FOV: 45 degrees:
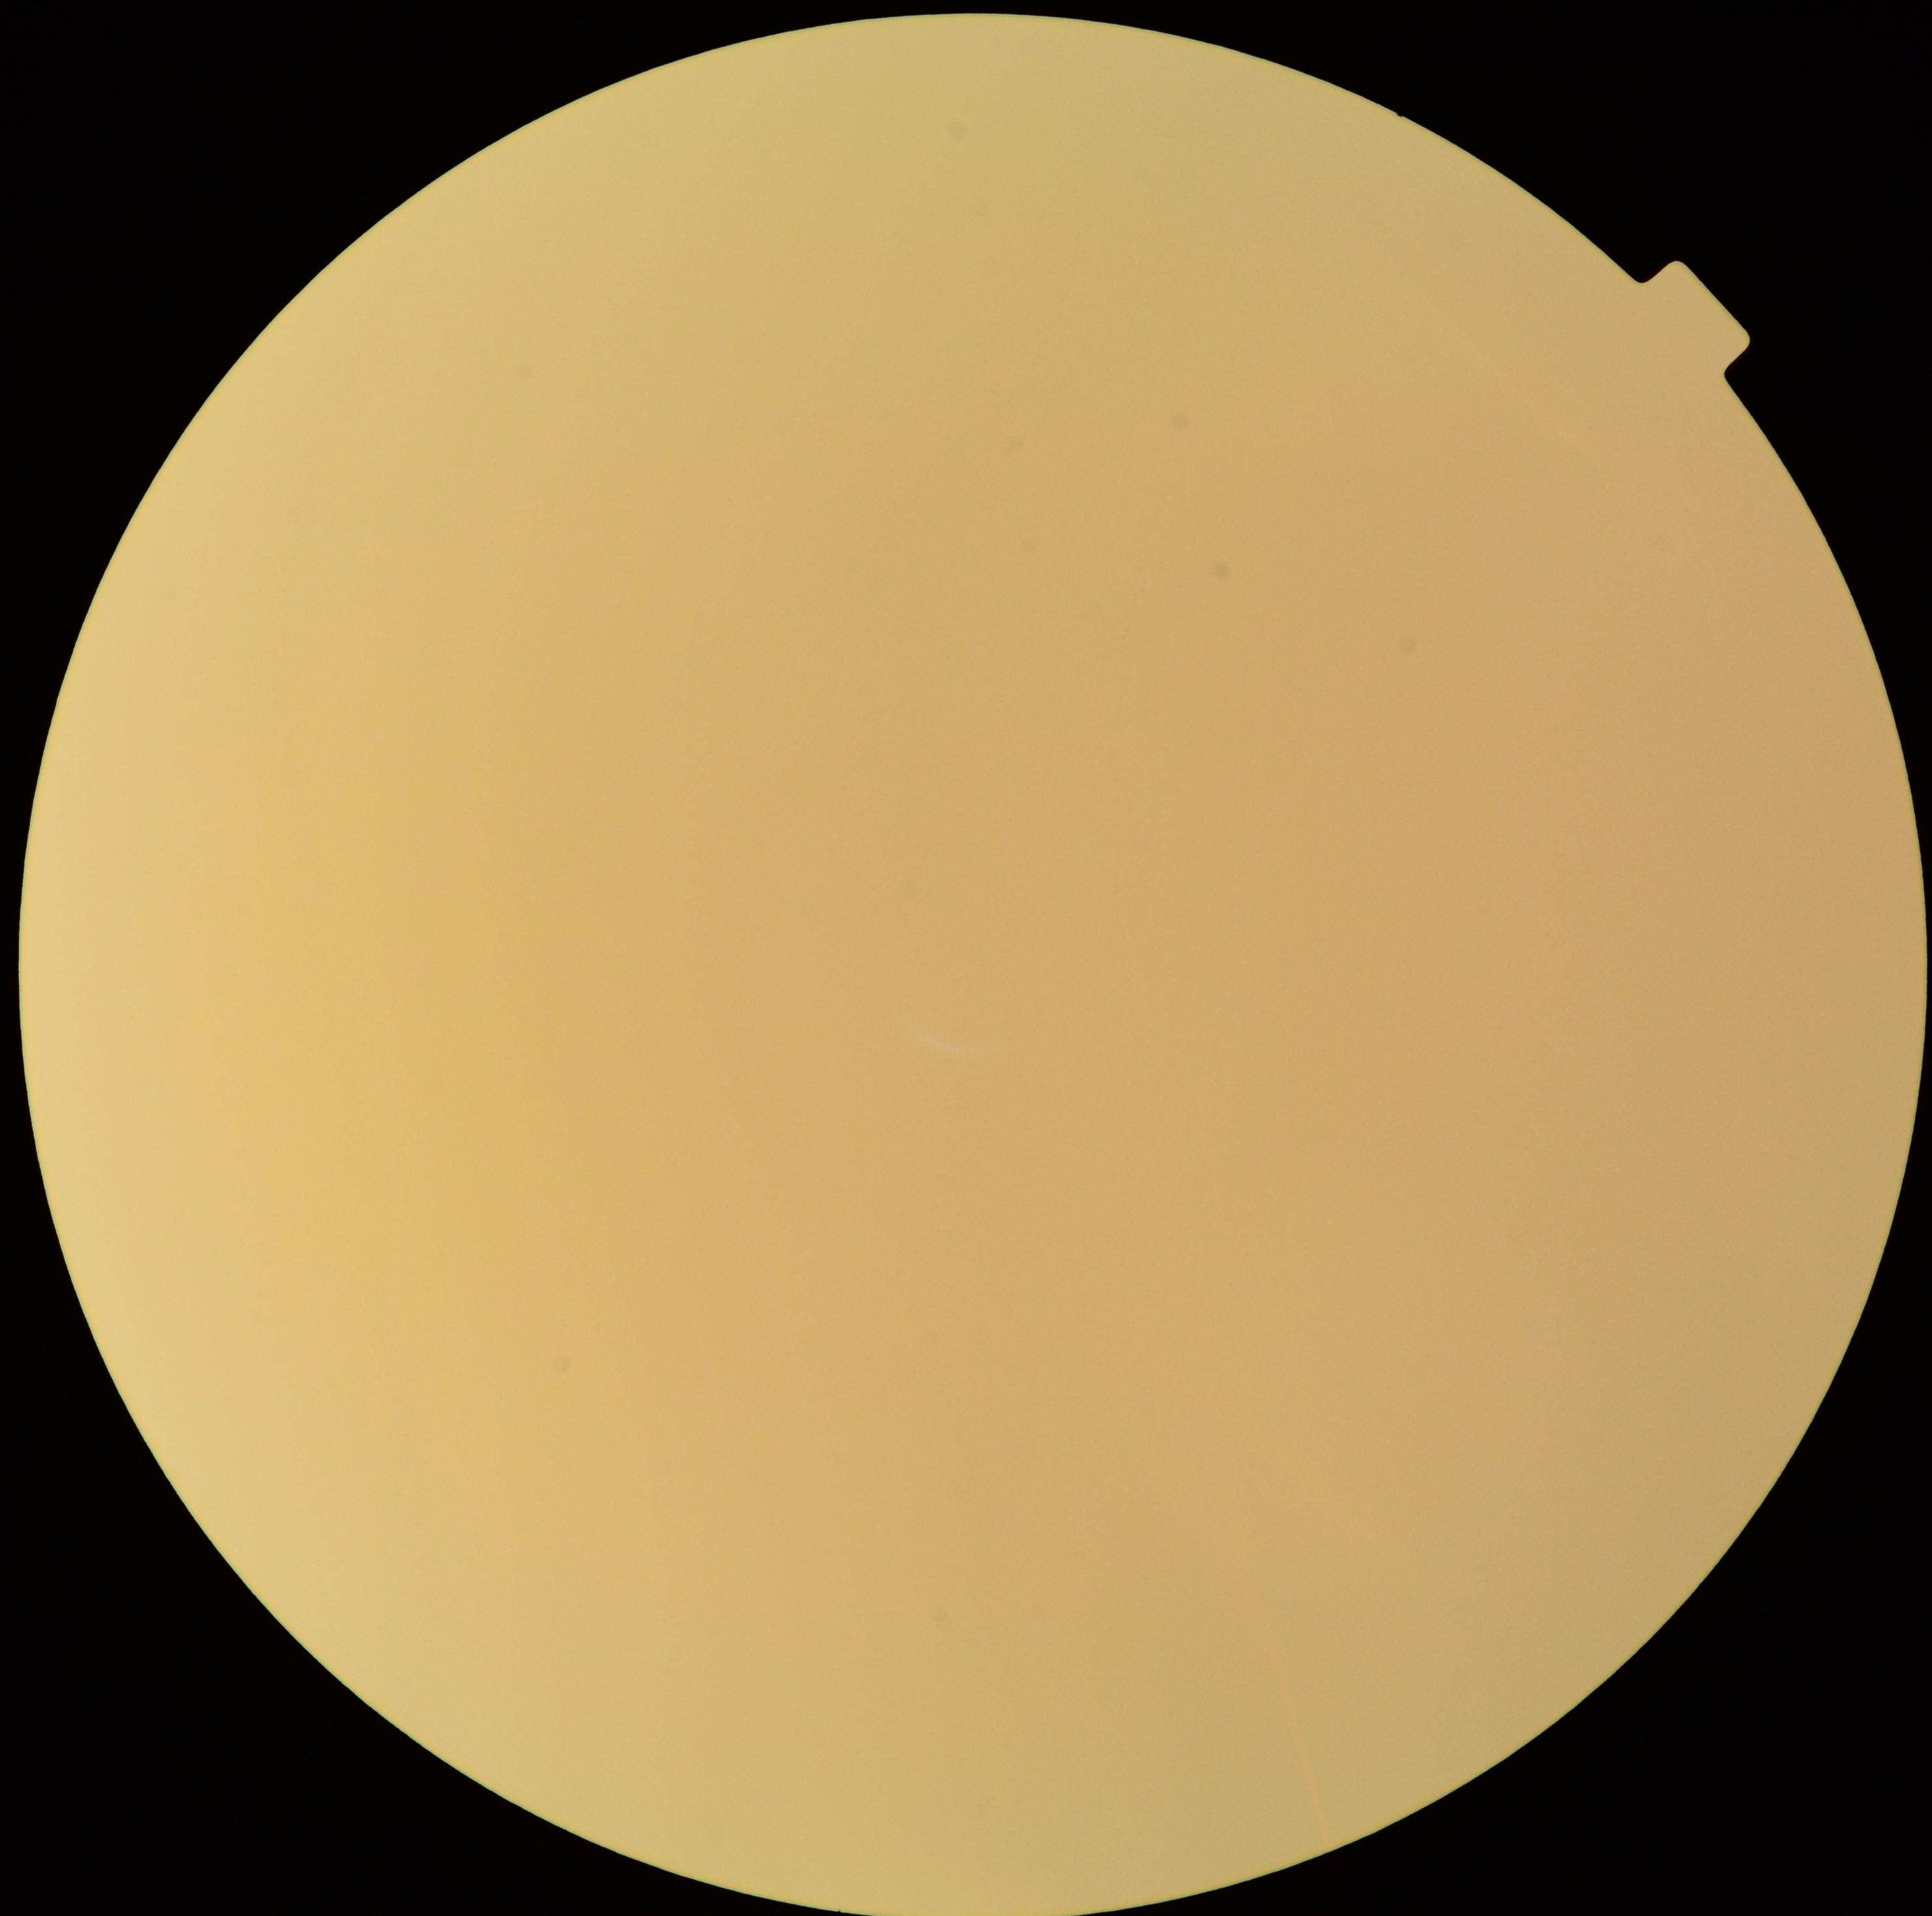
The image cannot be graded for diabetic retinopathy. DR stage is ungradable.